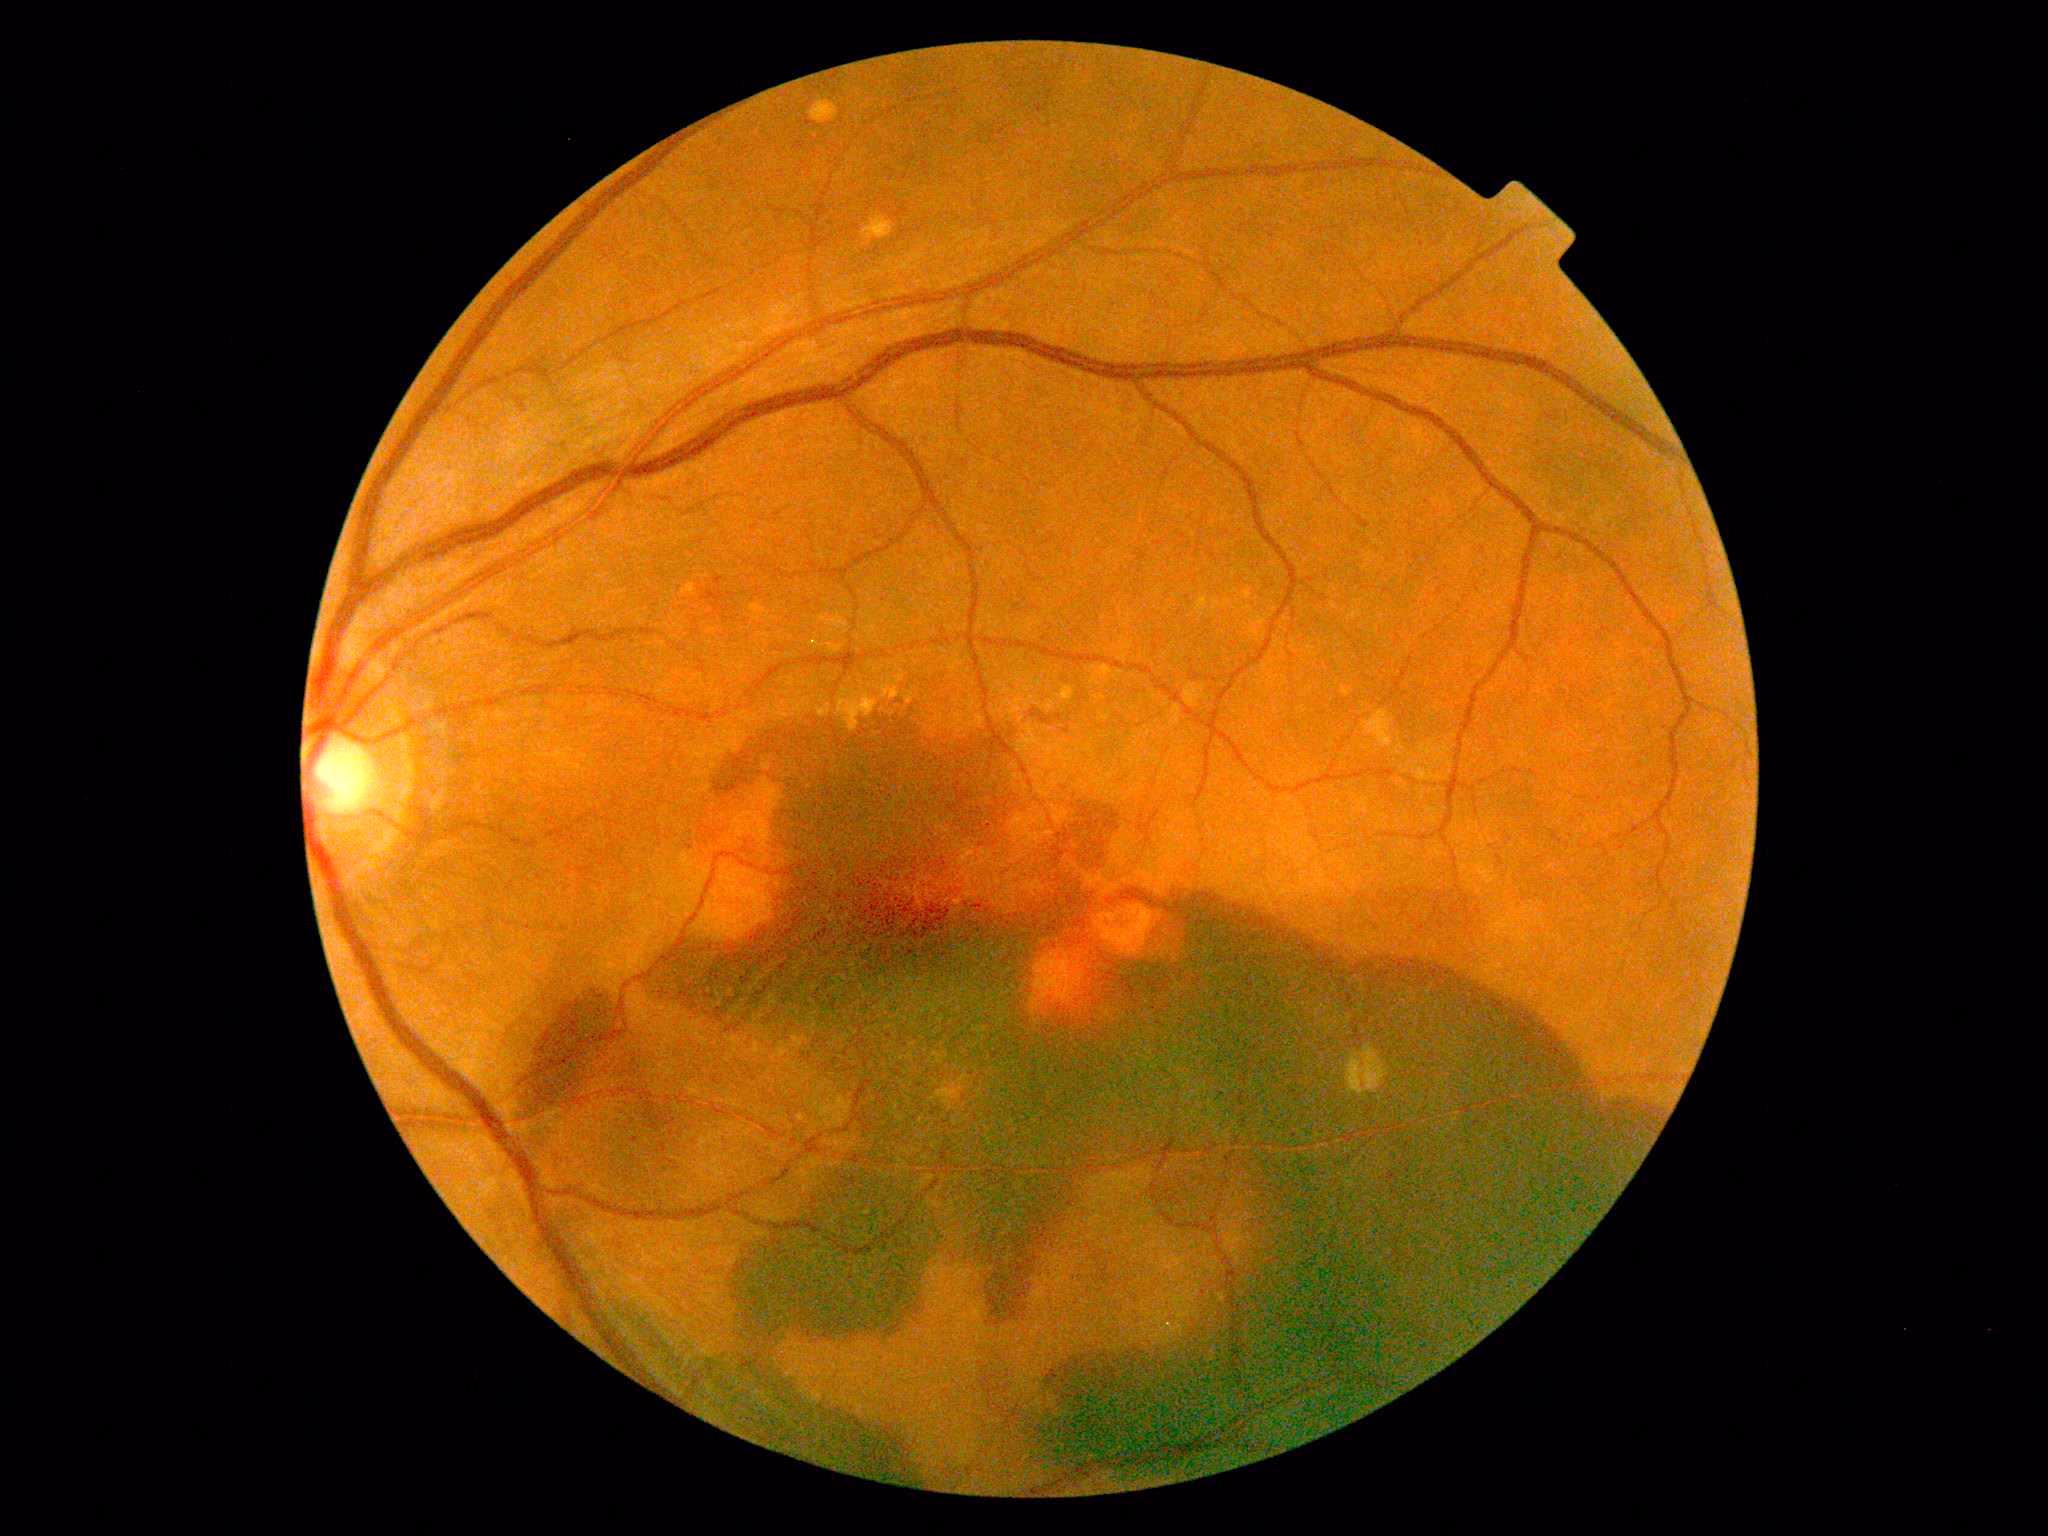

Diabetic retinopathy grade is PDR (4).